Camera: Topcon TRC-50DX. Mydriatic (tropicamide and phenylephrine). 50-degree field of view.
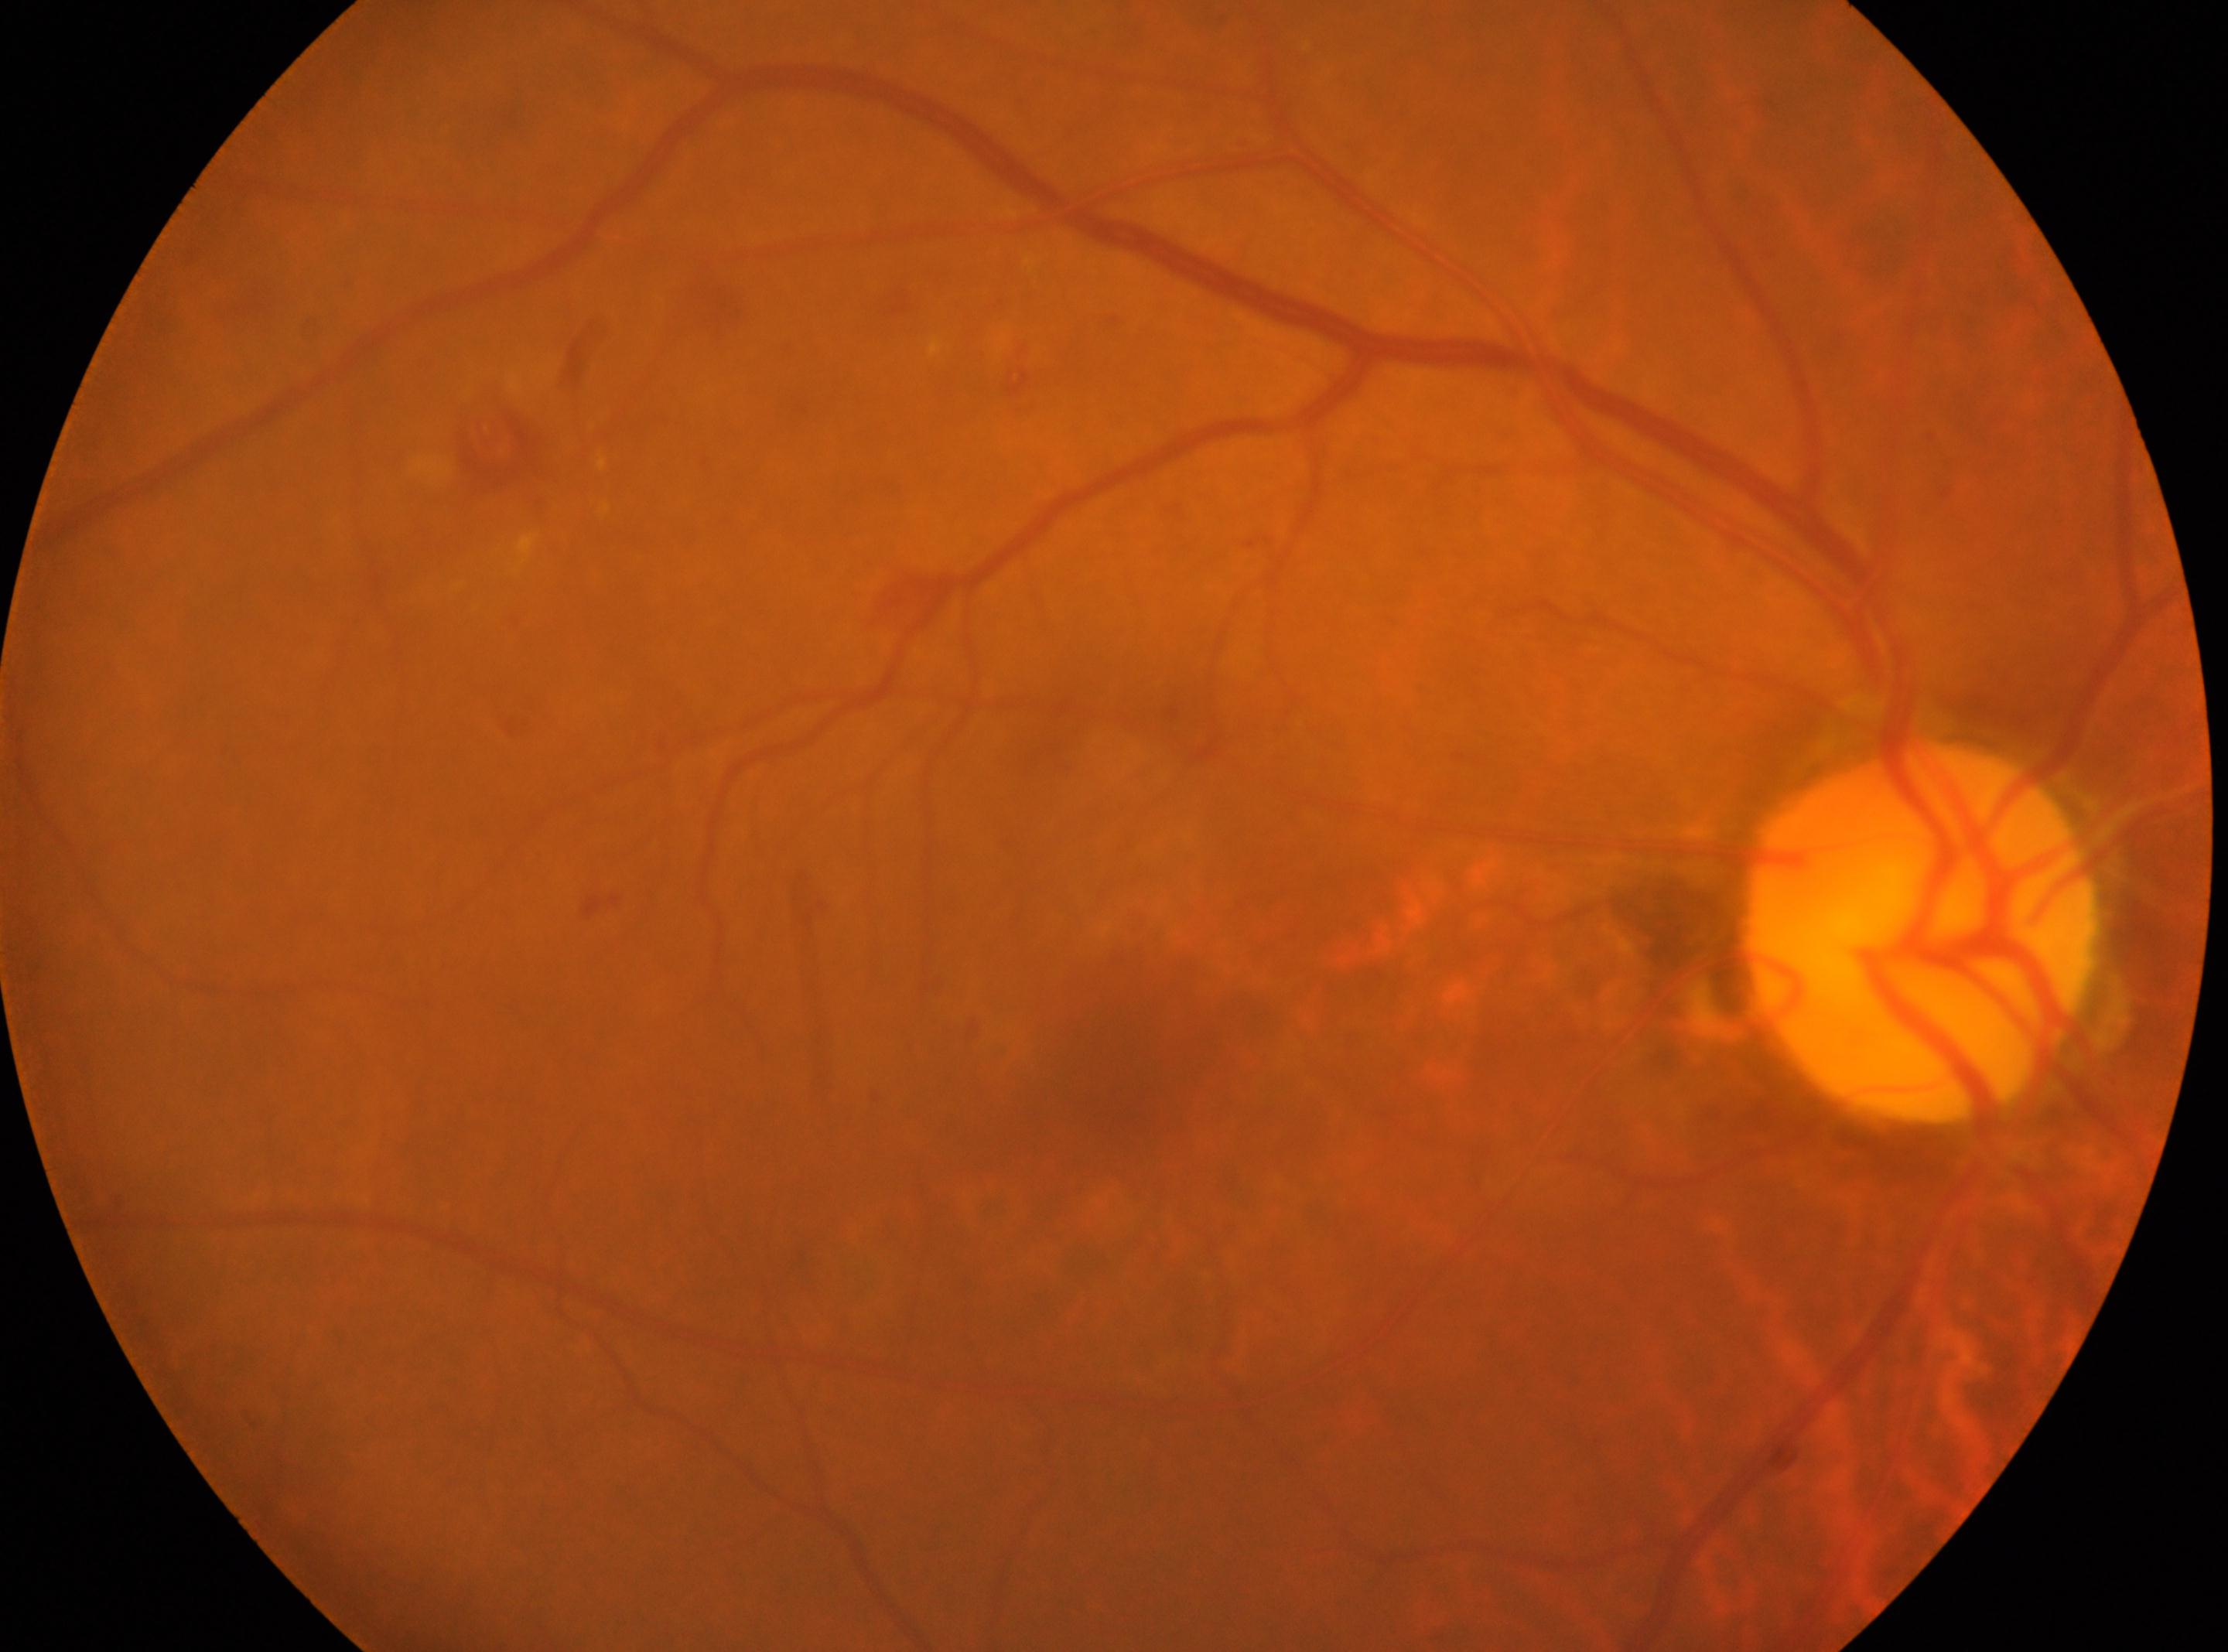

• fovea center — x=1117, y=1080
• laterality — right
• DR stage — grade 2 (moderate NPDR)
• the optic disc — x=1919, y=931